Nonmydriatic.
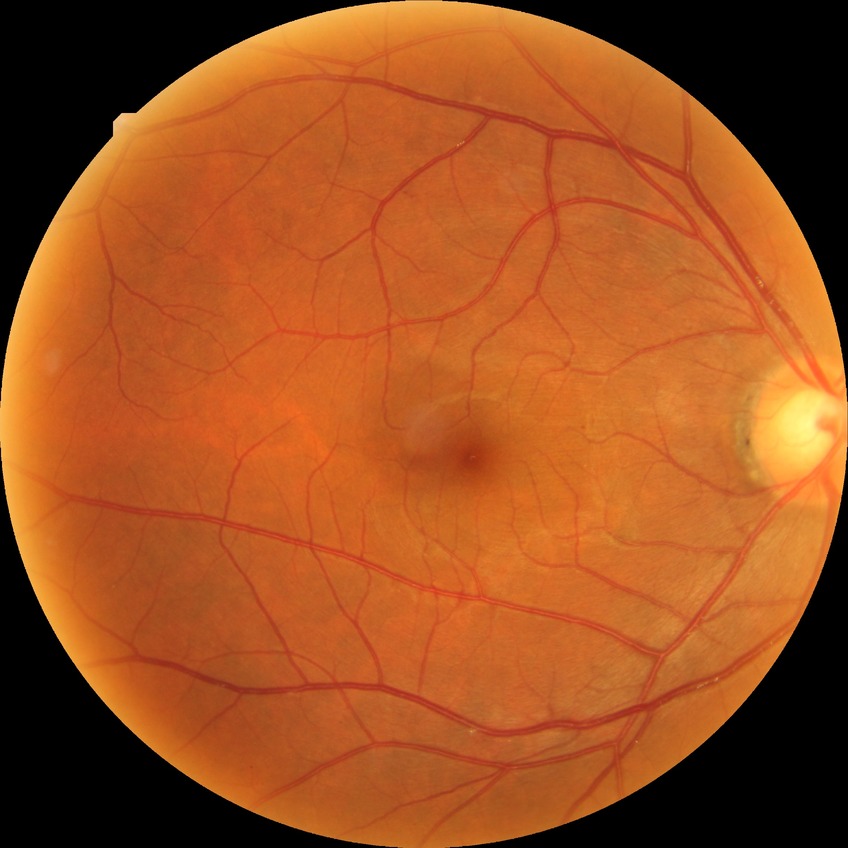 Retinopathy grade is no diabetic retinopathy.